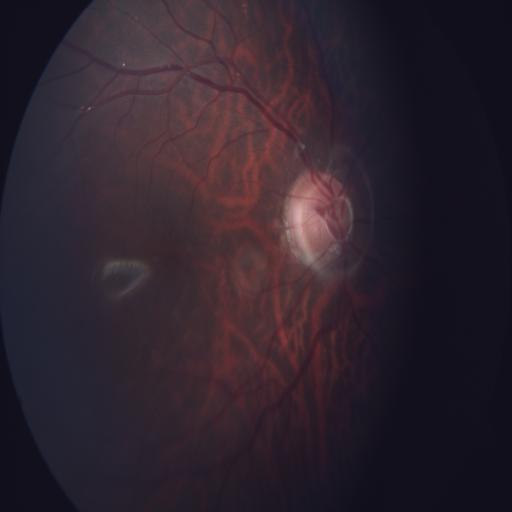

Abnormalities: tessellation (TSLN) | tilted disc (TD).